Wide-field fundus photograph of an infant.
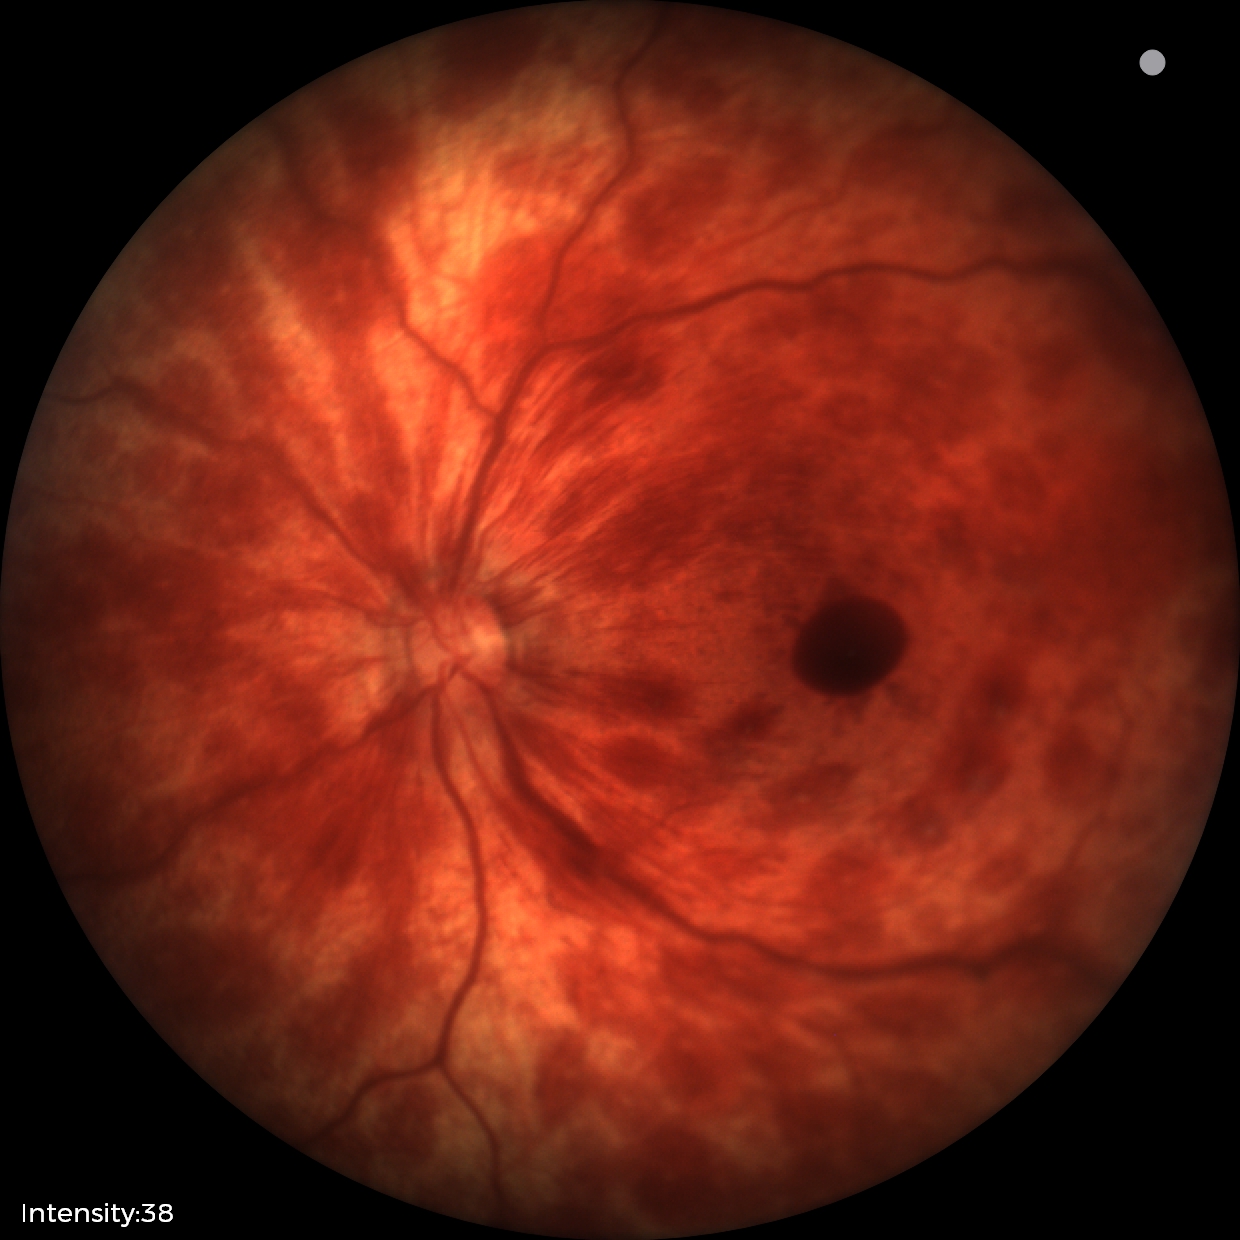
Examination diagnosed as retinal hemorrhages.